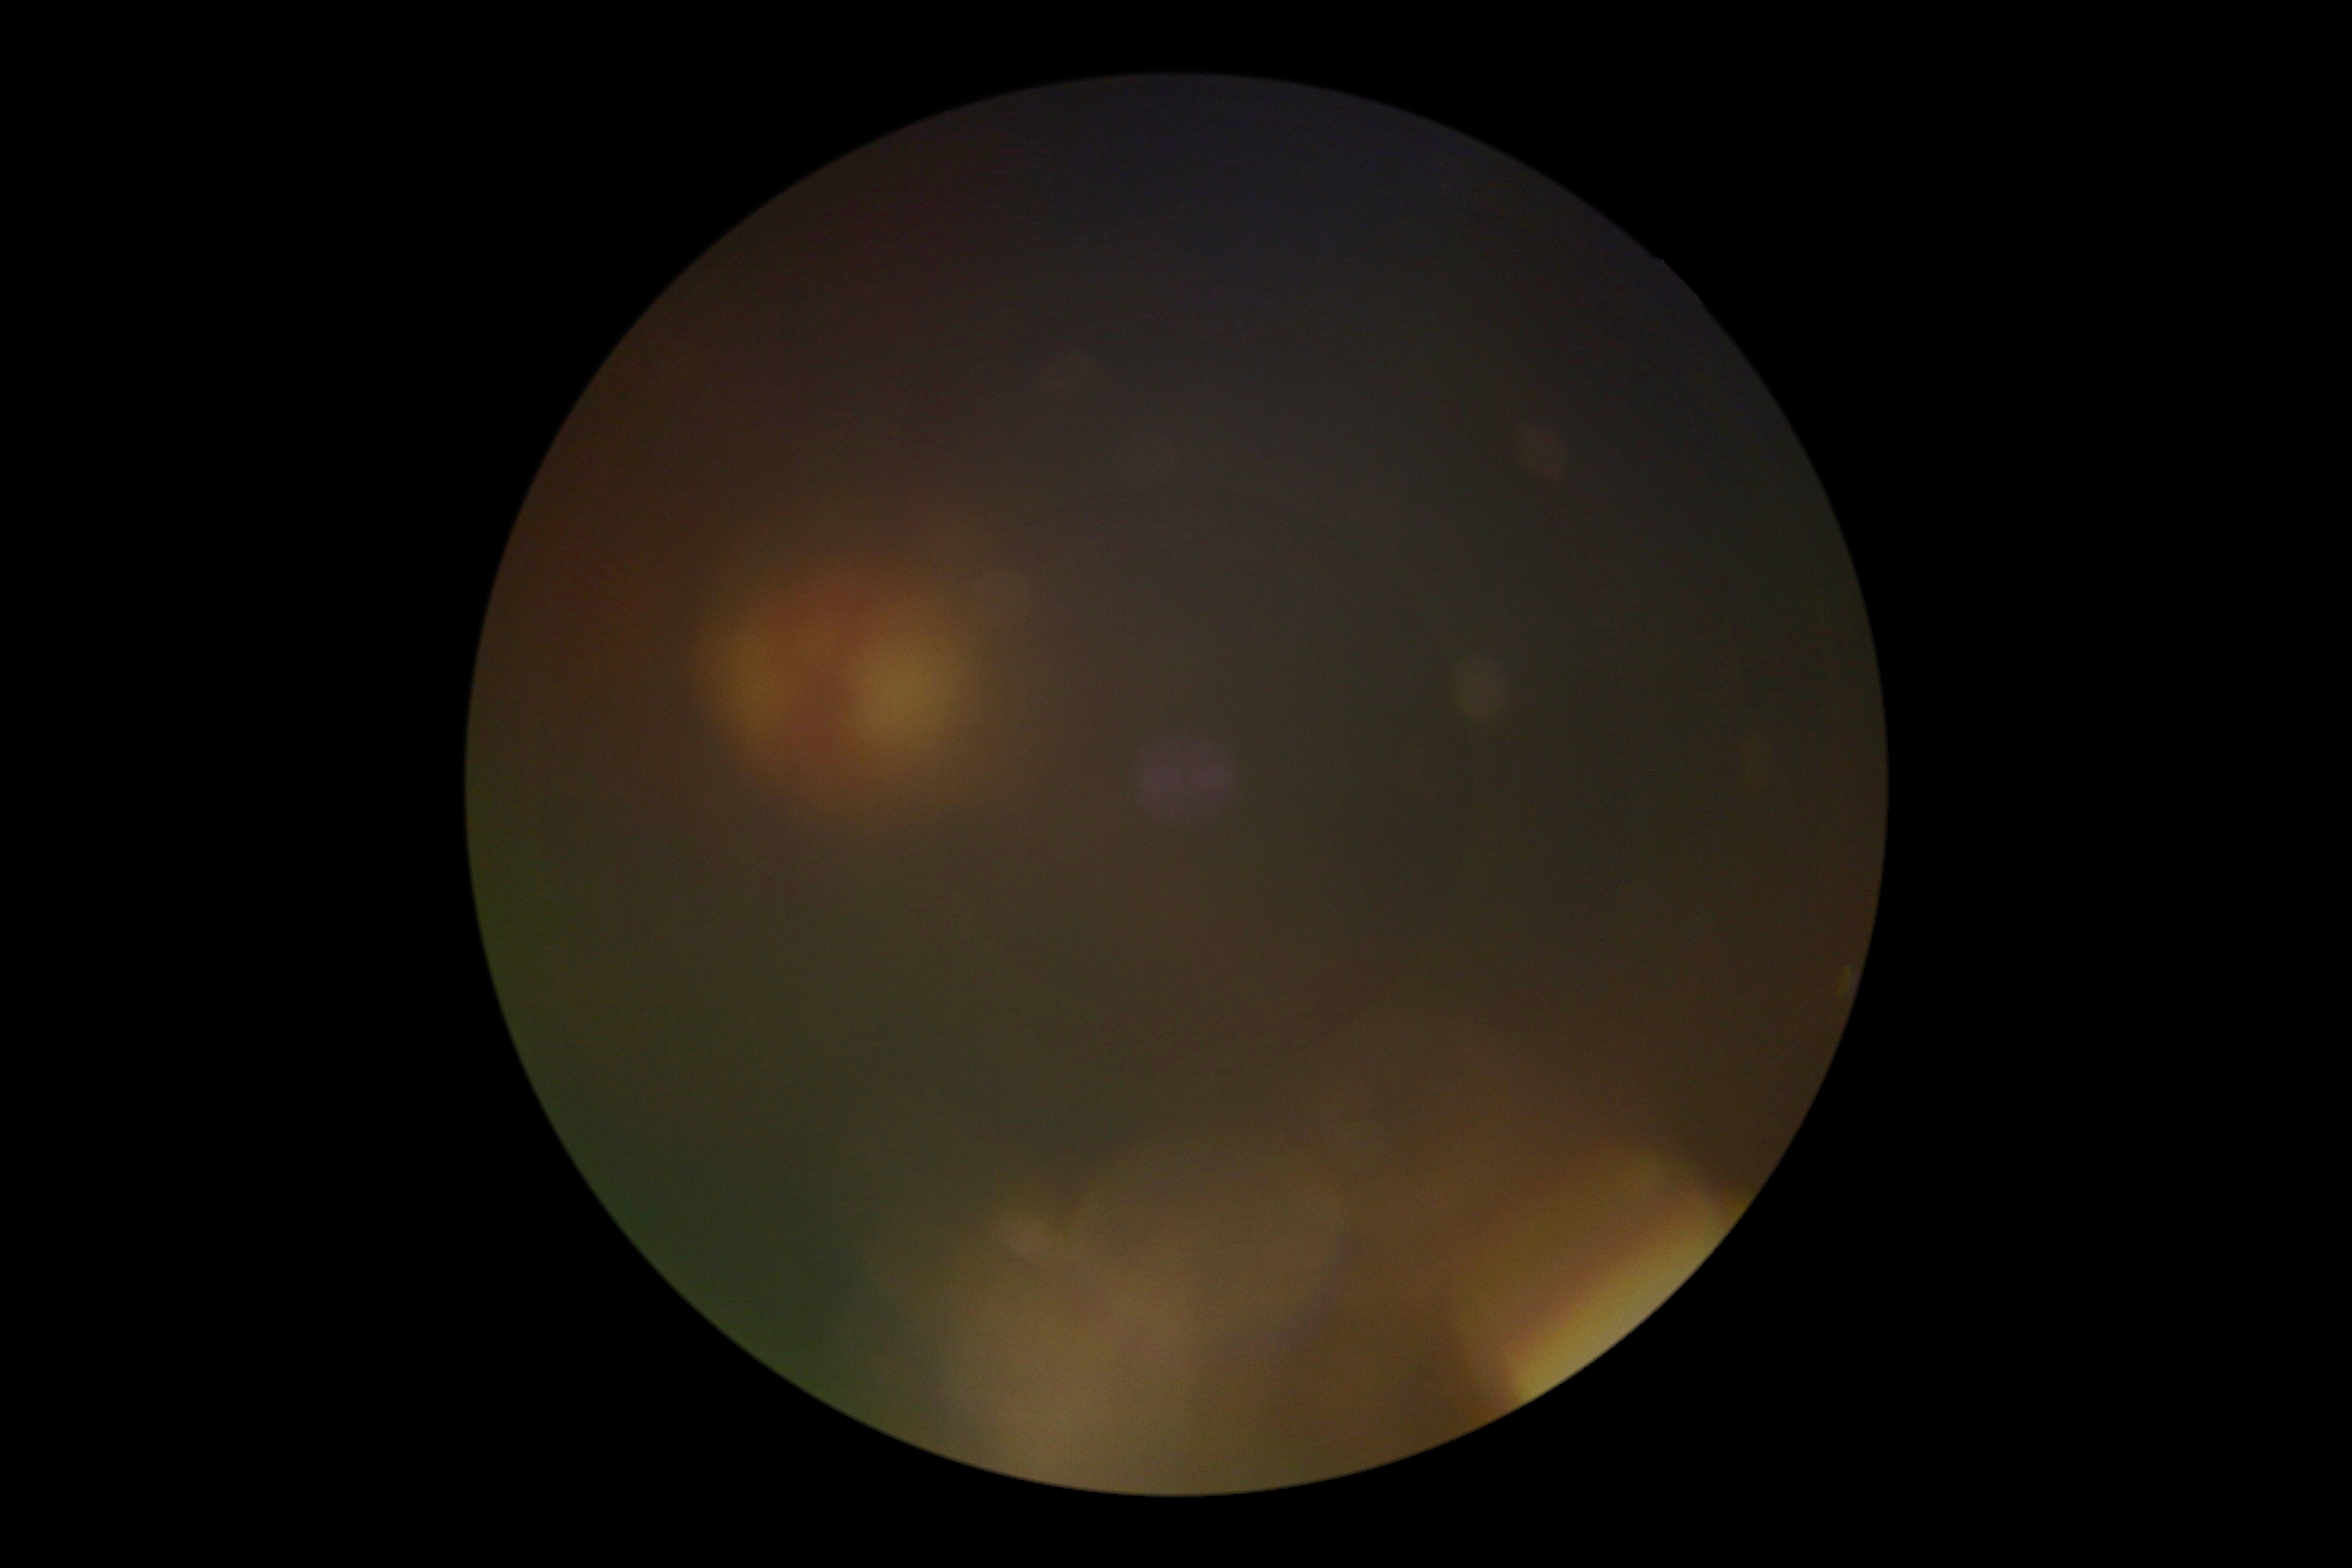

Annotations:
– image quality — too poor for DR grading
– DR grade — ungradable due to poor image quality